CFP:
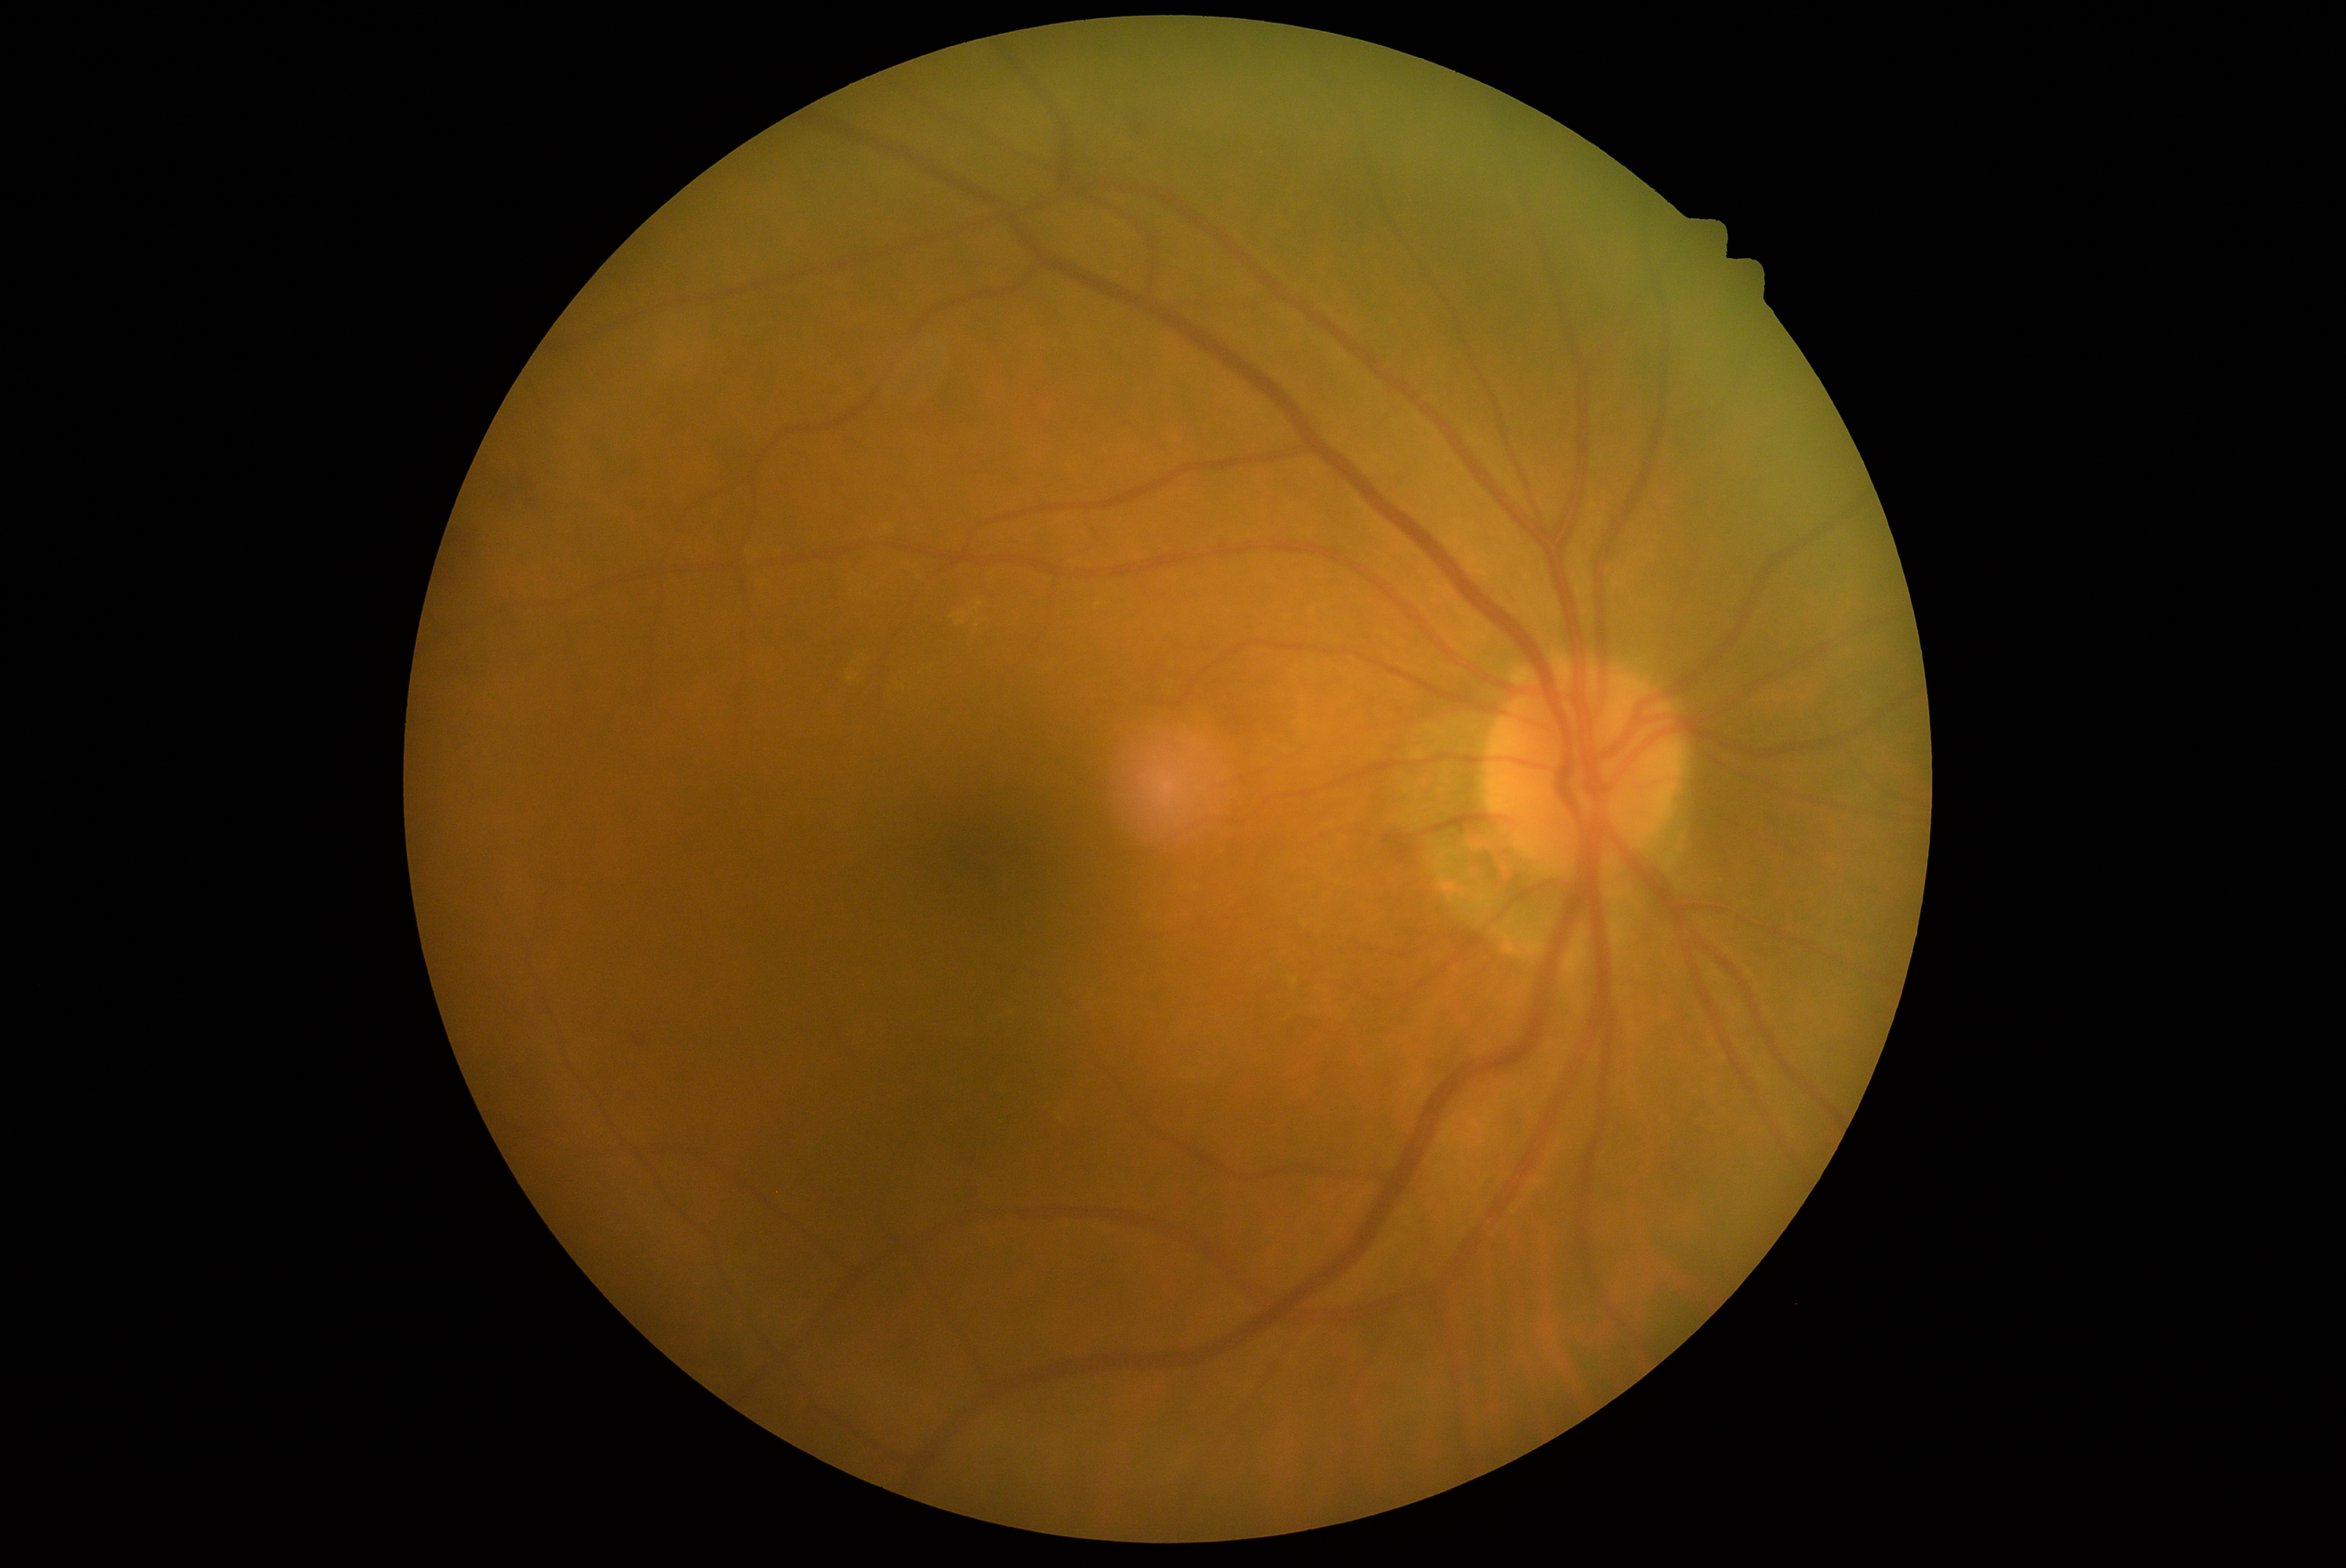

Annotations:
• retinopathy grade — 2 (moderate NPDR)